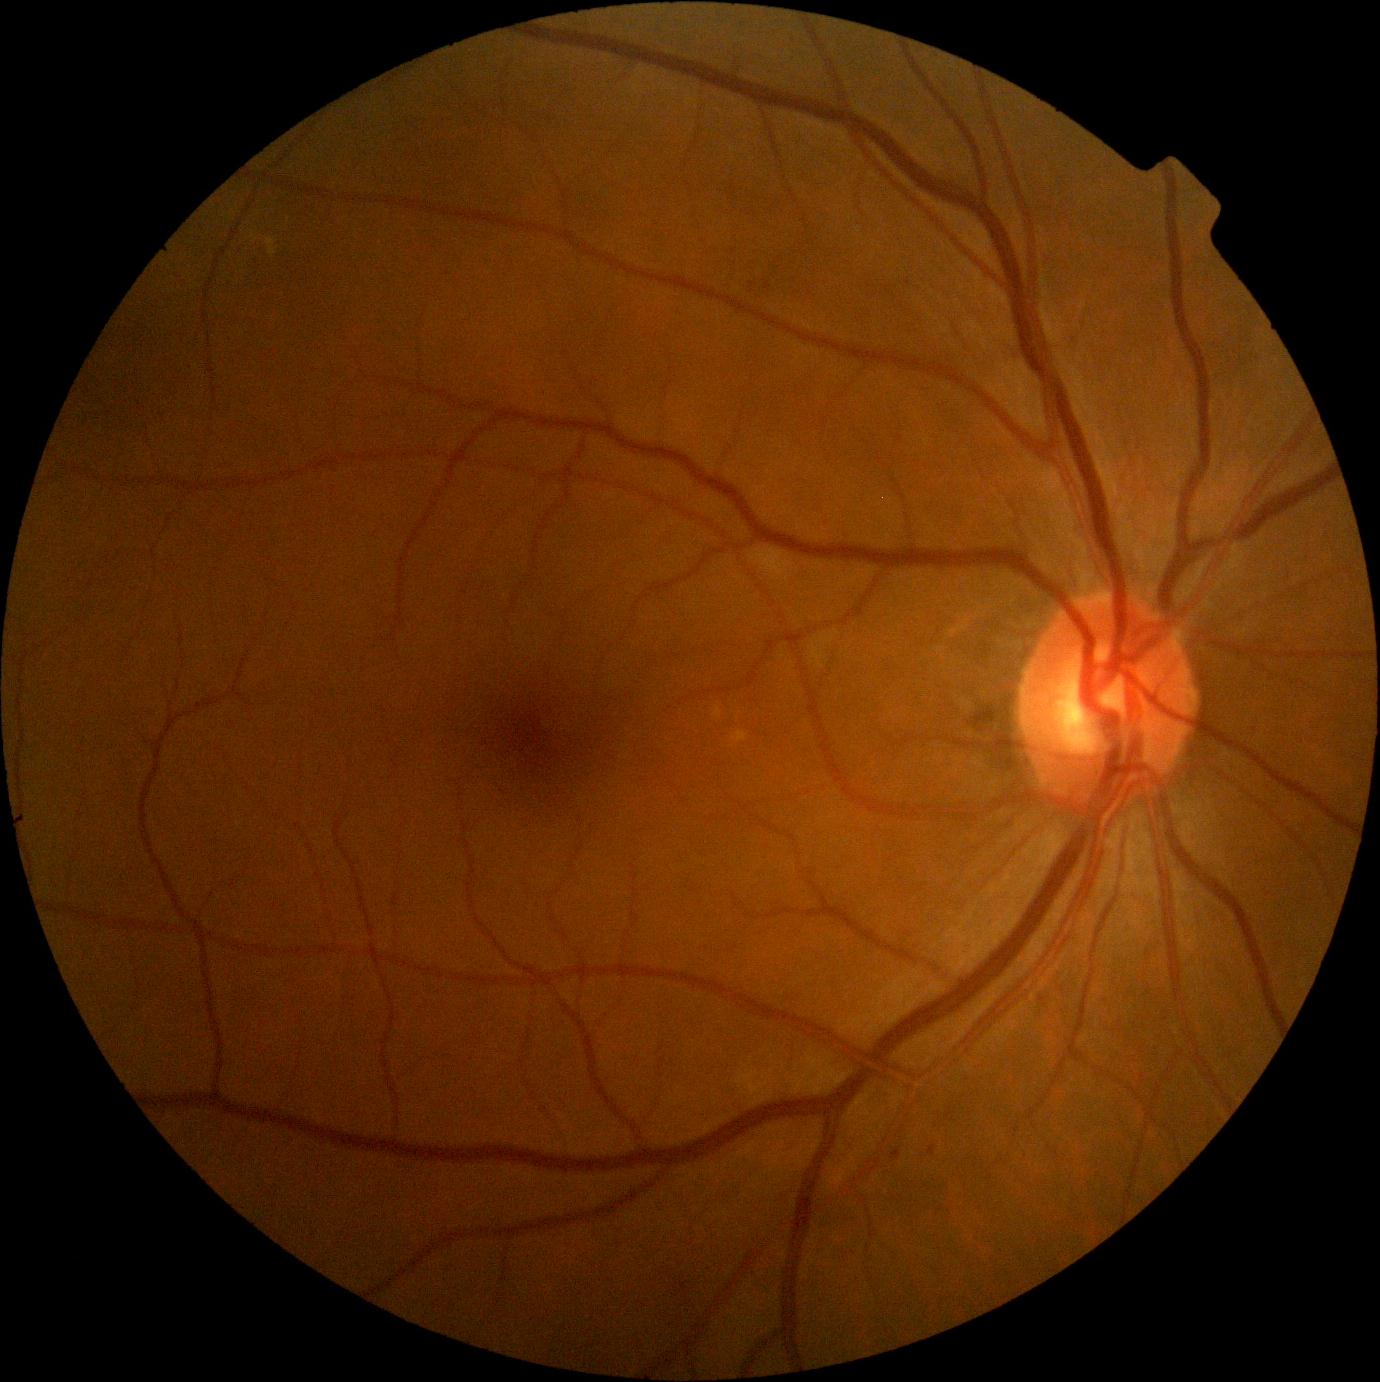 Retinopathy: grade 1
Lesions identified (partial list):
hemorrhages = none
soft exudates = none
microaneurysms (continued) = [929,1146,937,1156], [891,1150,902,1160]
Additional small microaneurysms near [x=1042, y=999]
hard exudates = none